1960x1897, fundus photo.
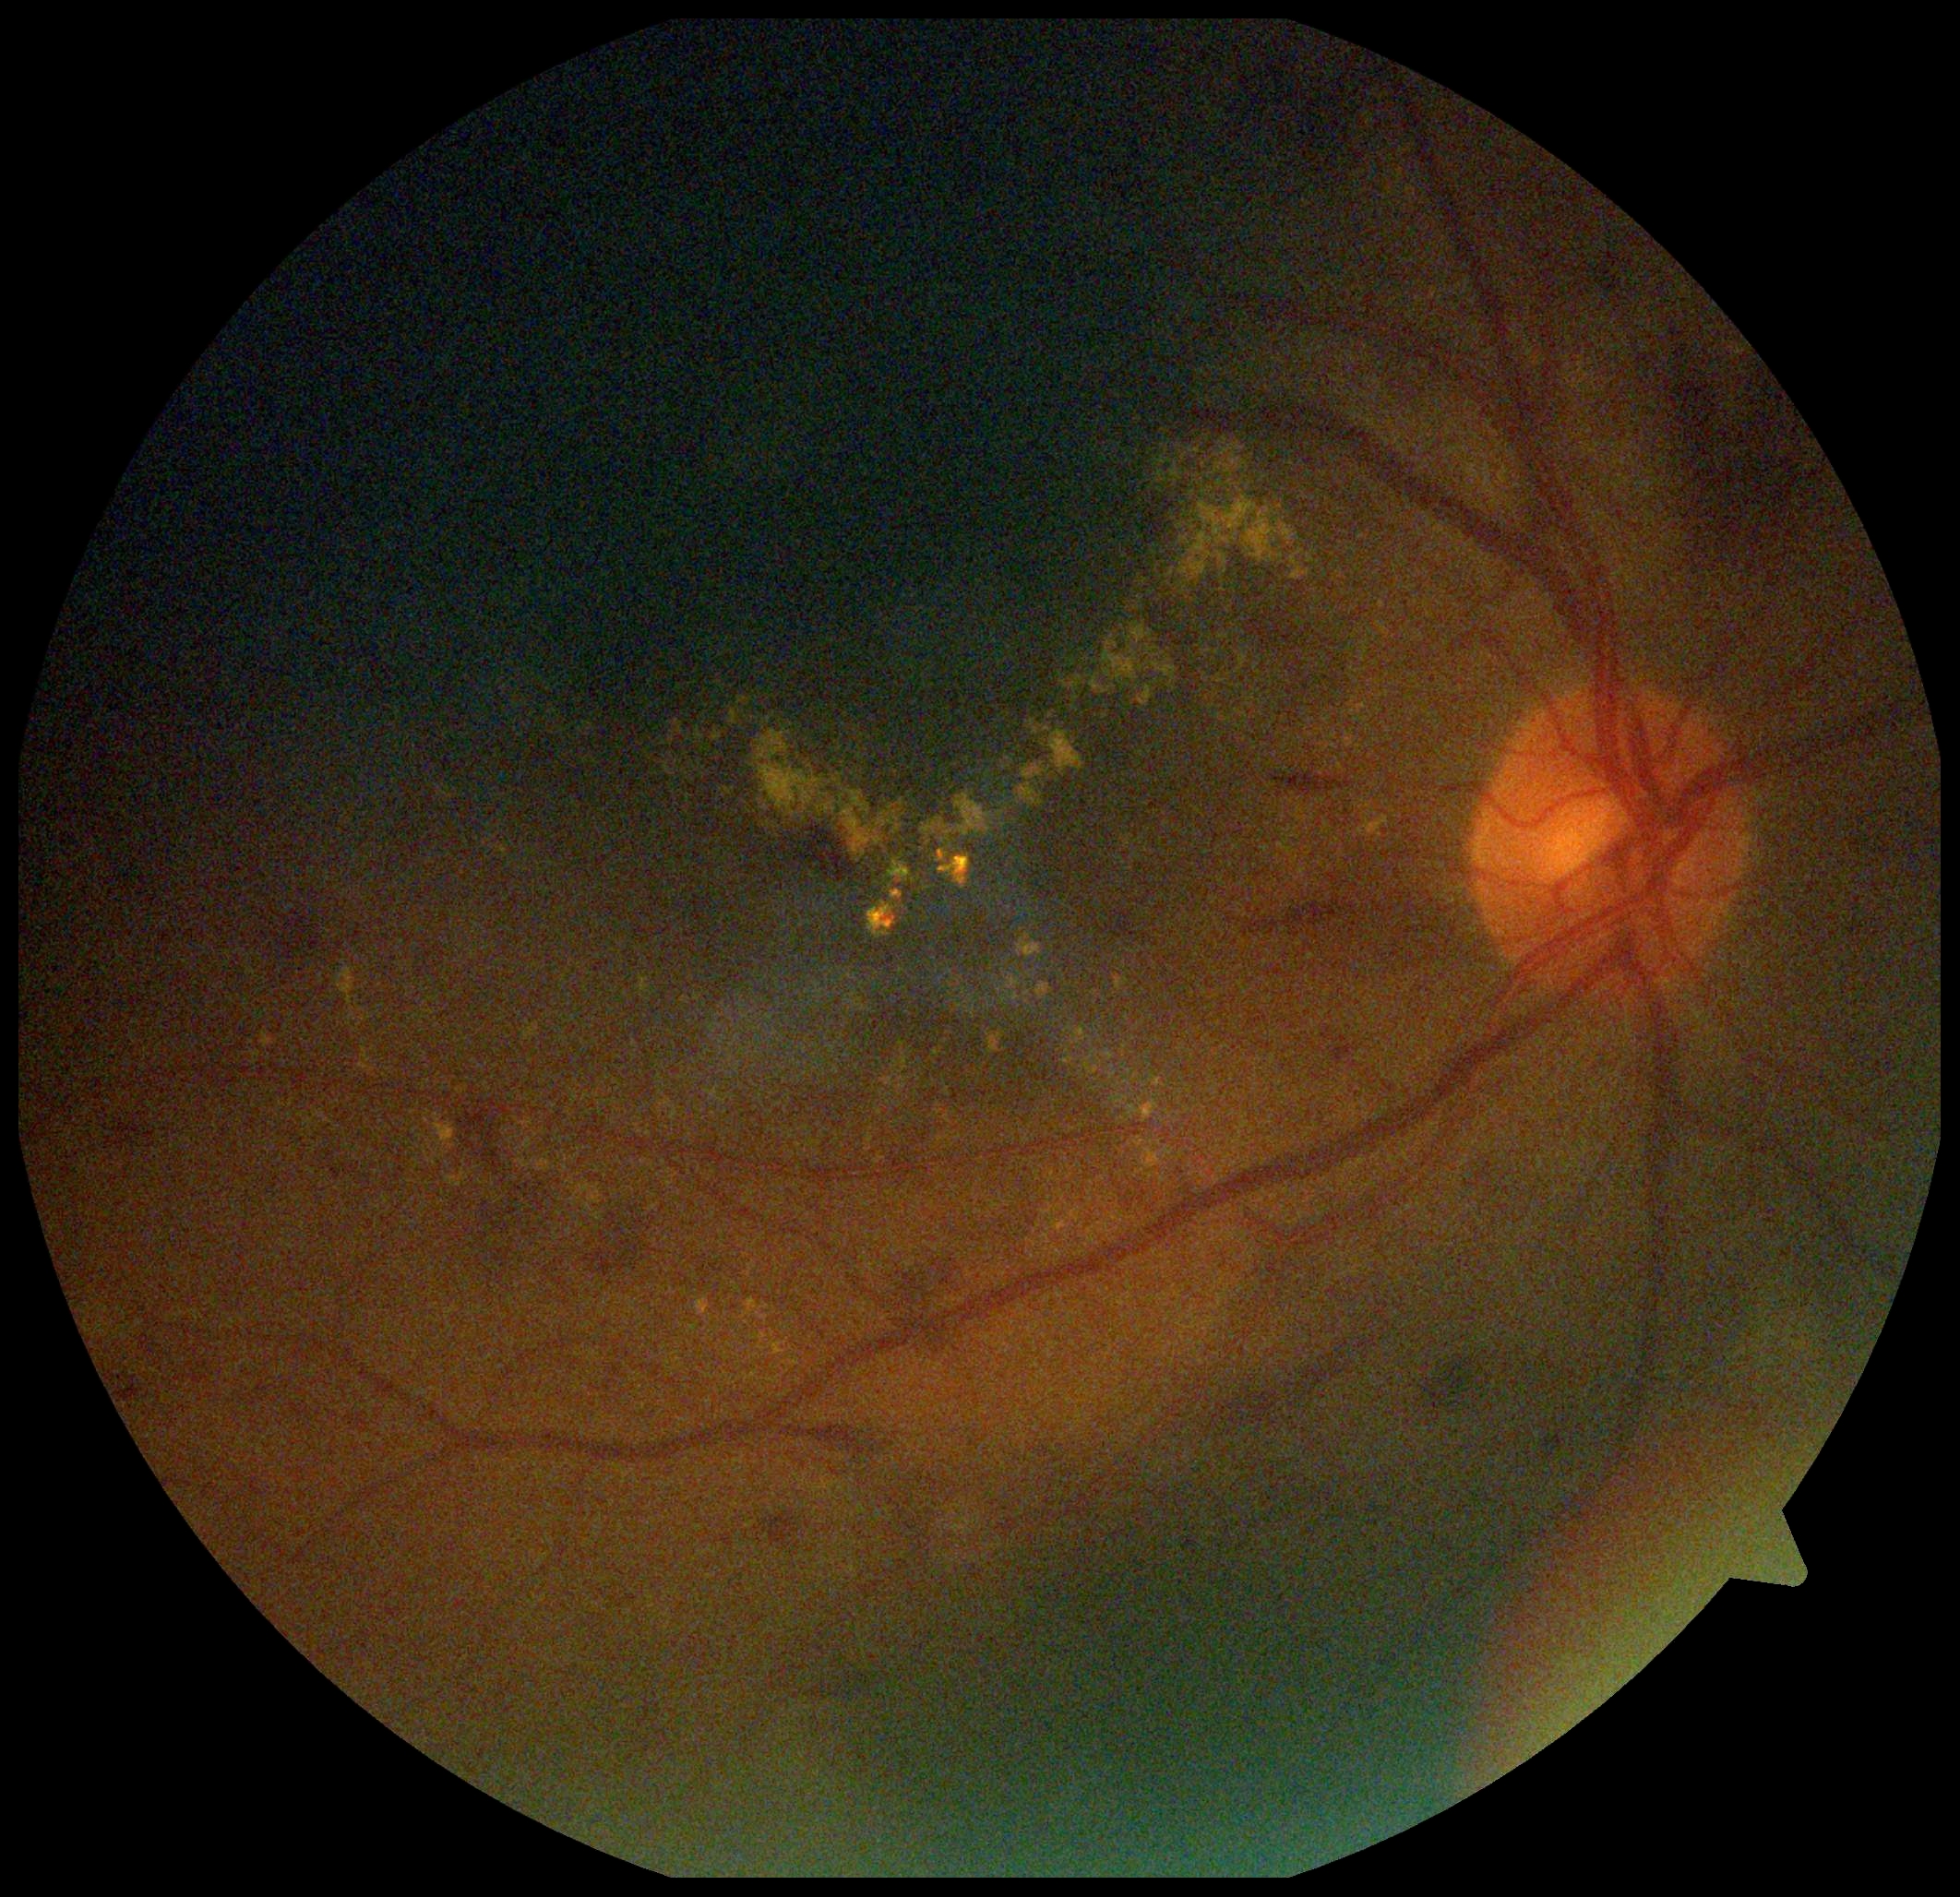
Retinopathy grade is moderate NPDR (2).